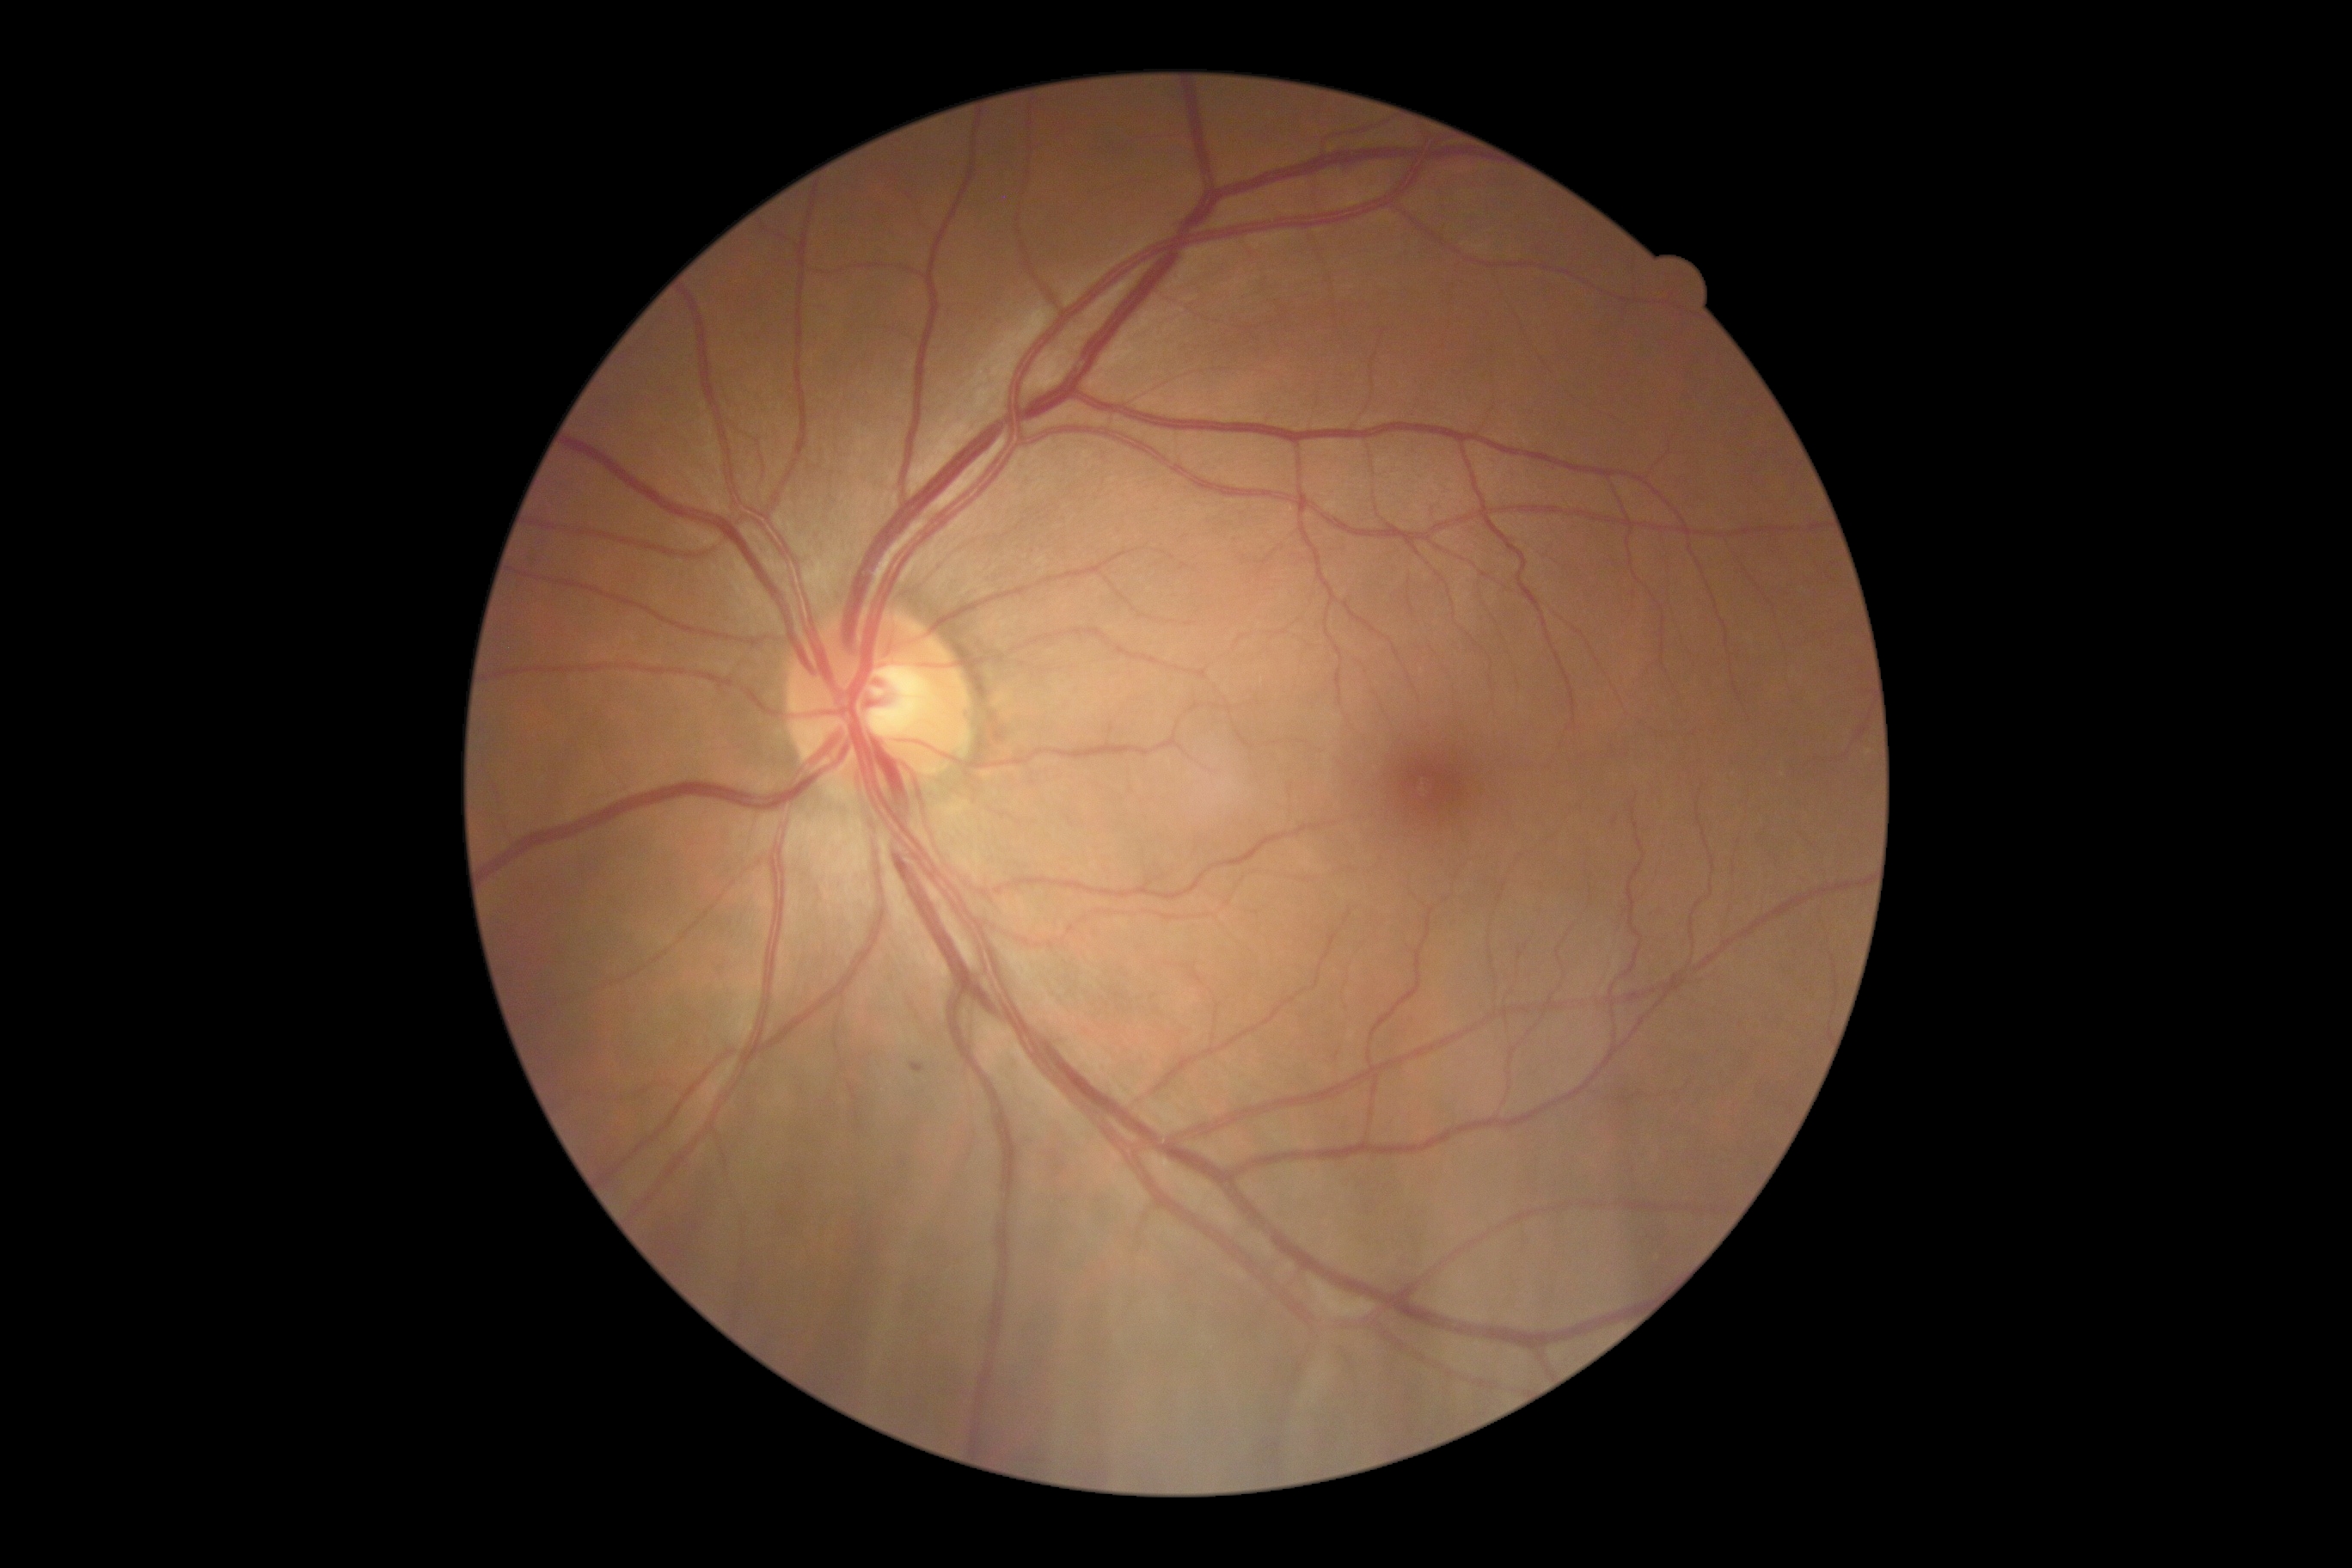

{"dr_grade":1,"lesions":{"ex":null,"se":null,"ma":[[910,1063,926,1074]],"he":null}}